Image size 640x480; acquired on the Clarity RetCam 3; wide-field fundus photograph from neonatal ROP screening.
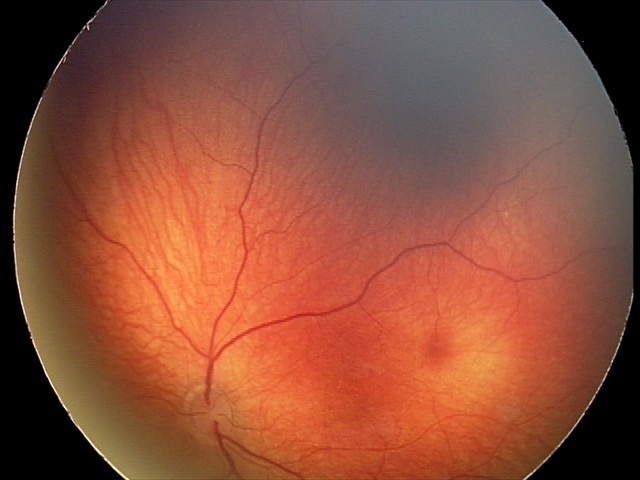
Diagnosis: retinal hemorrhages.